2352x1568.
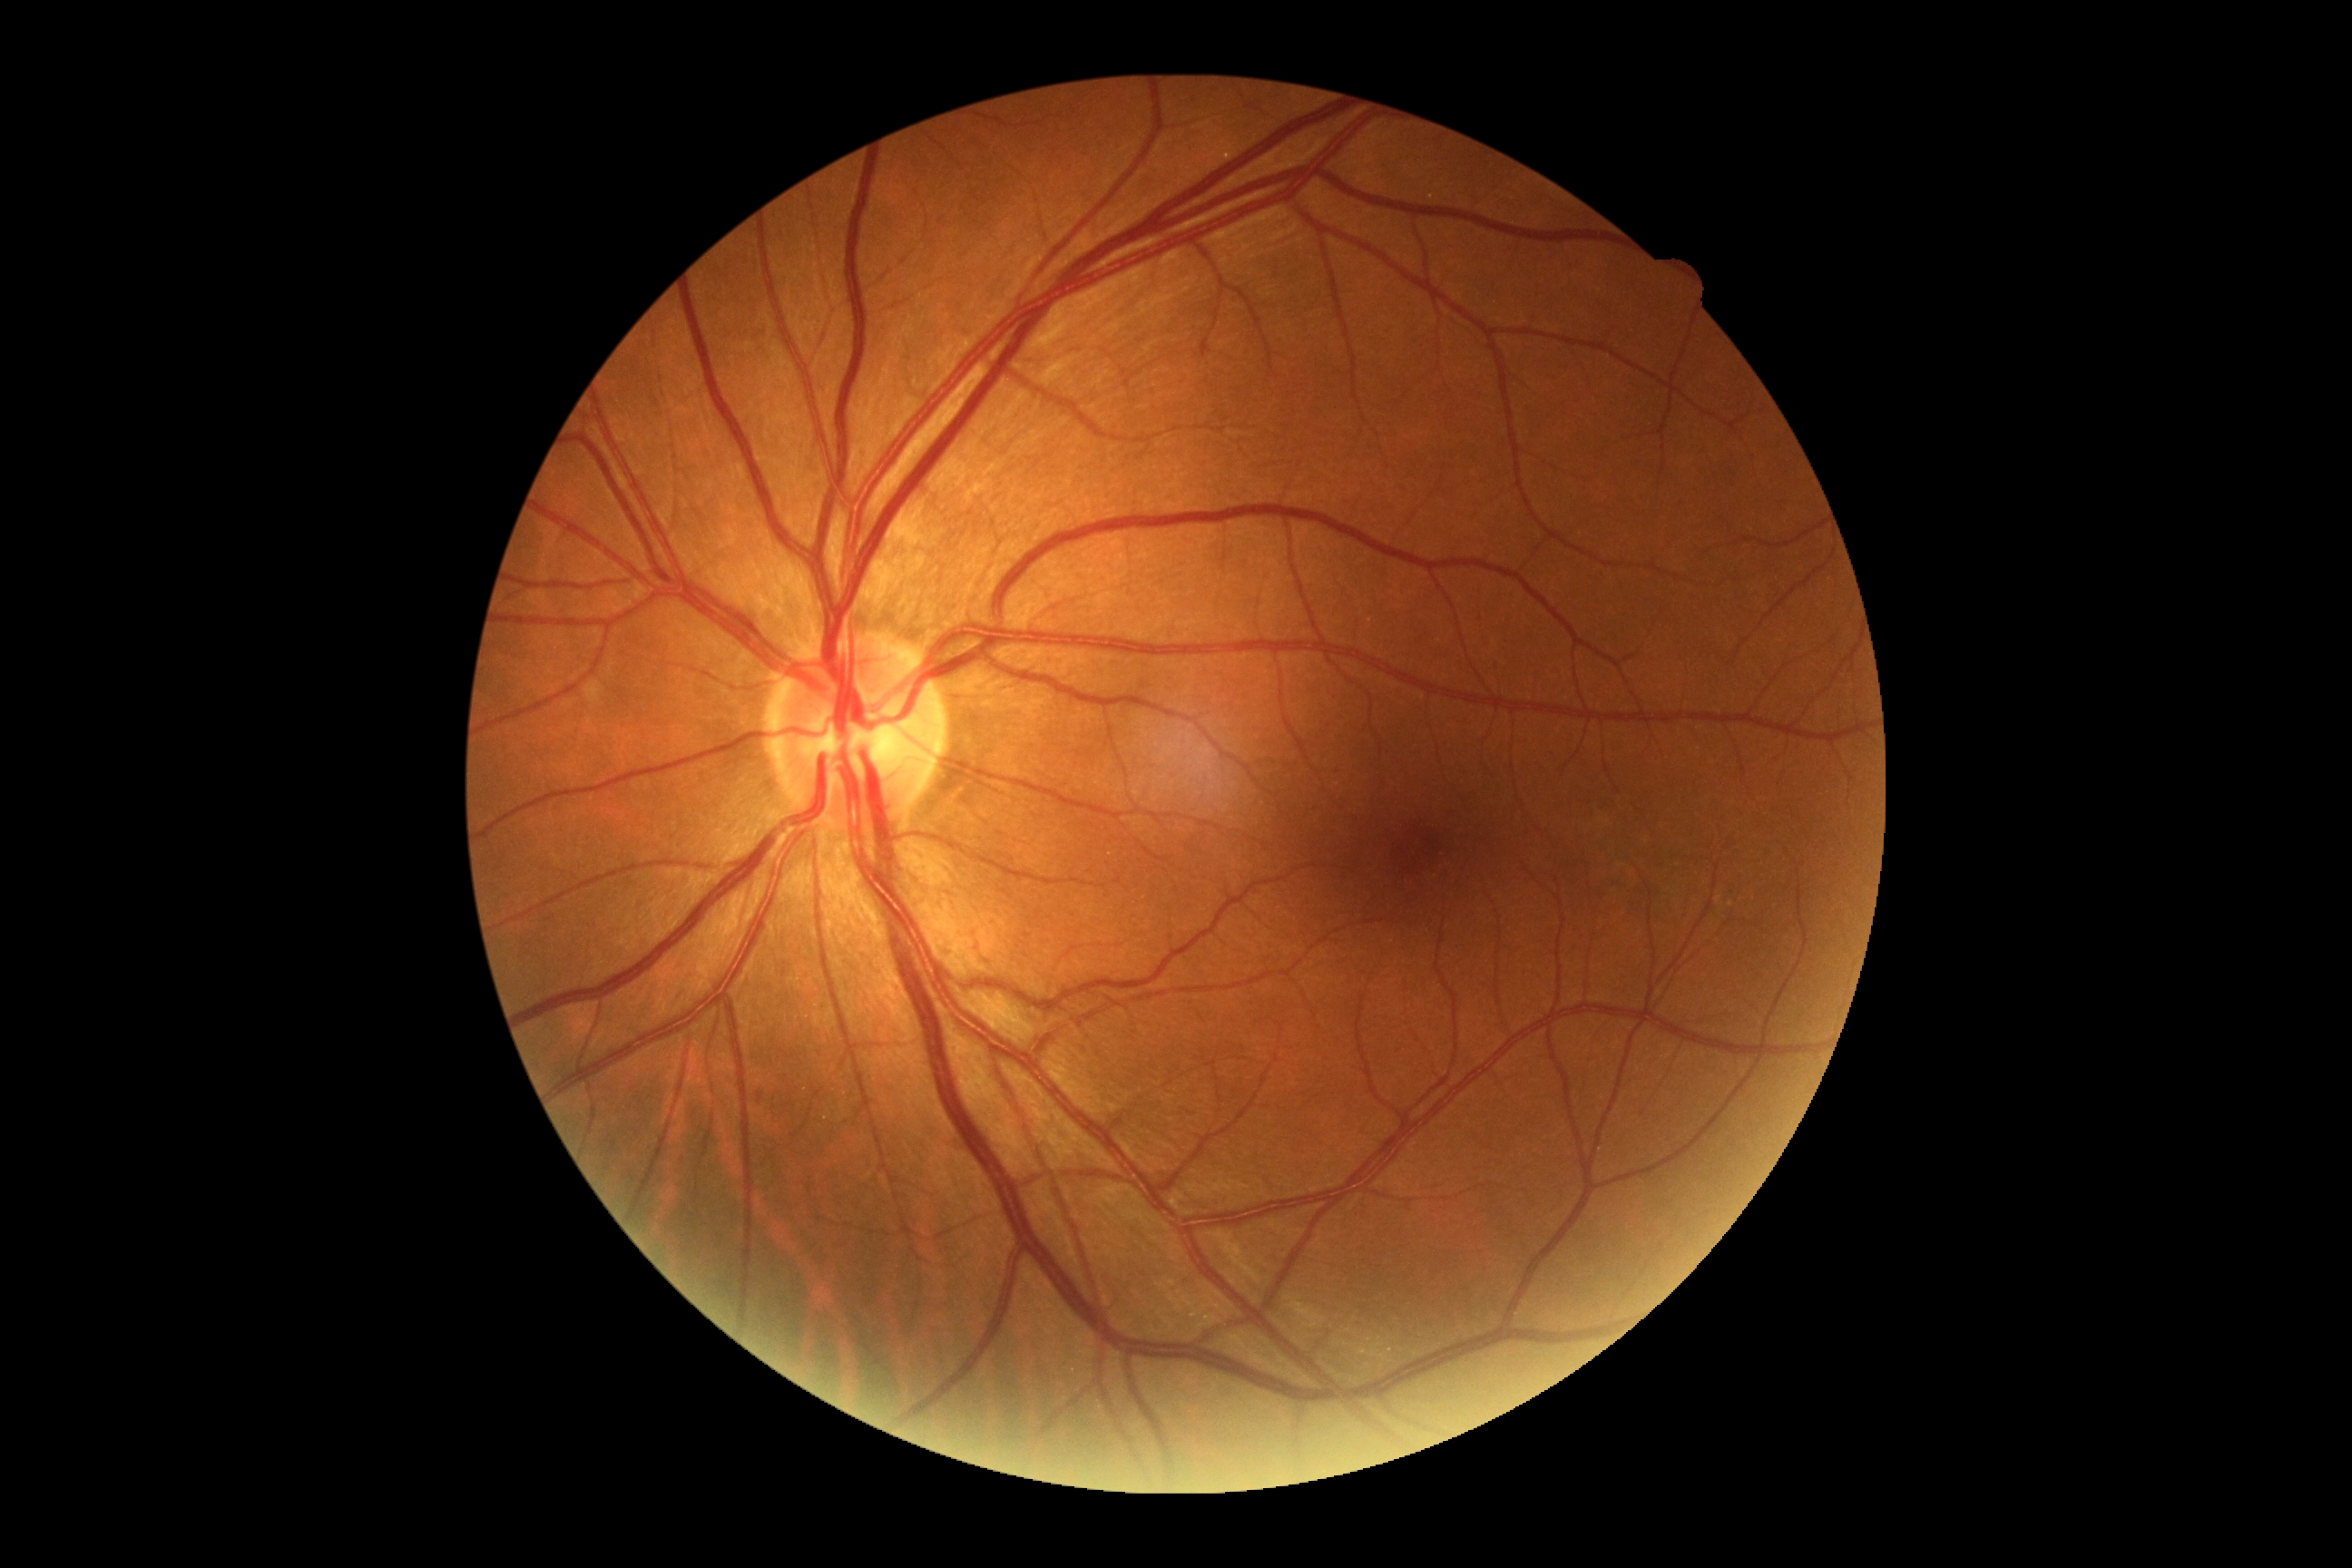 {
  "dr_grade": "0 (no apparent retinopathy)"
}